2352 x 1568 pixels, 45° FOV, color fundus photograph
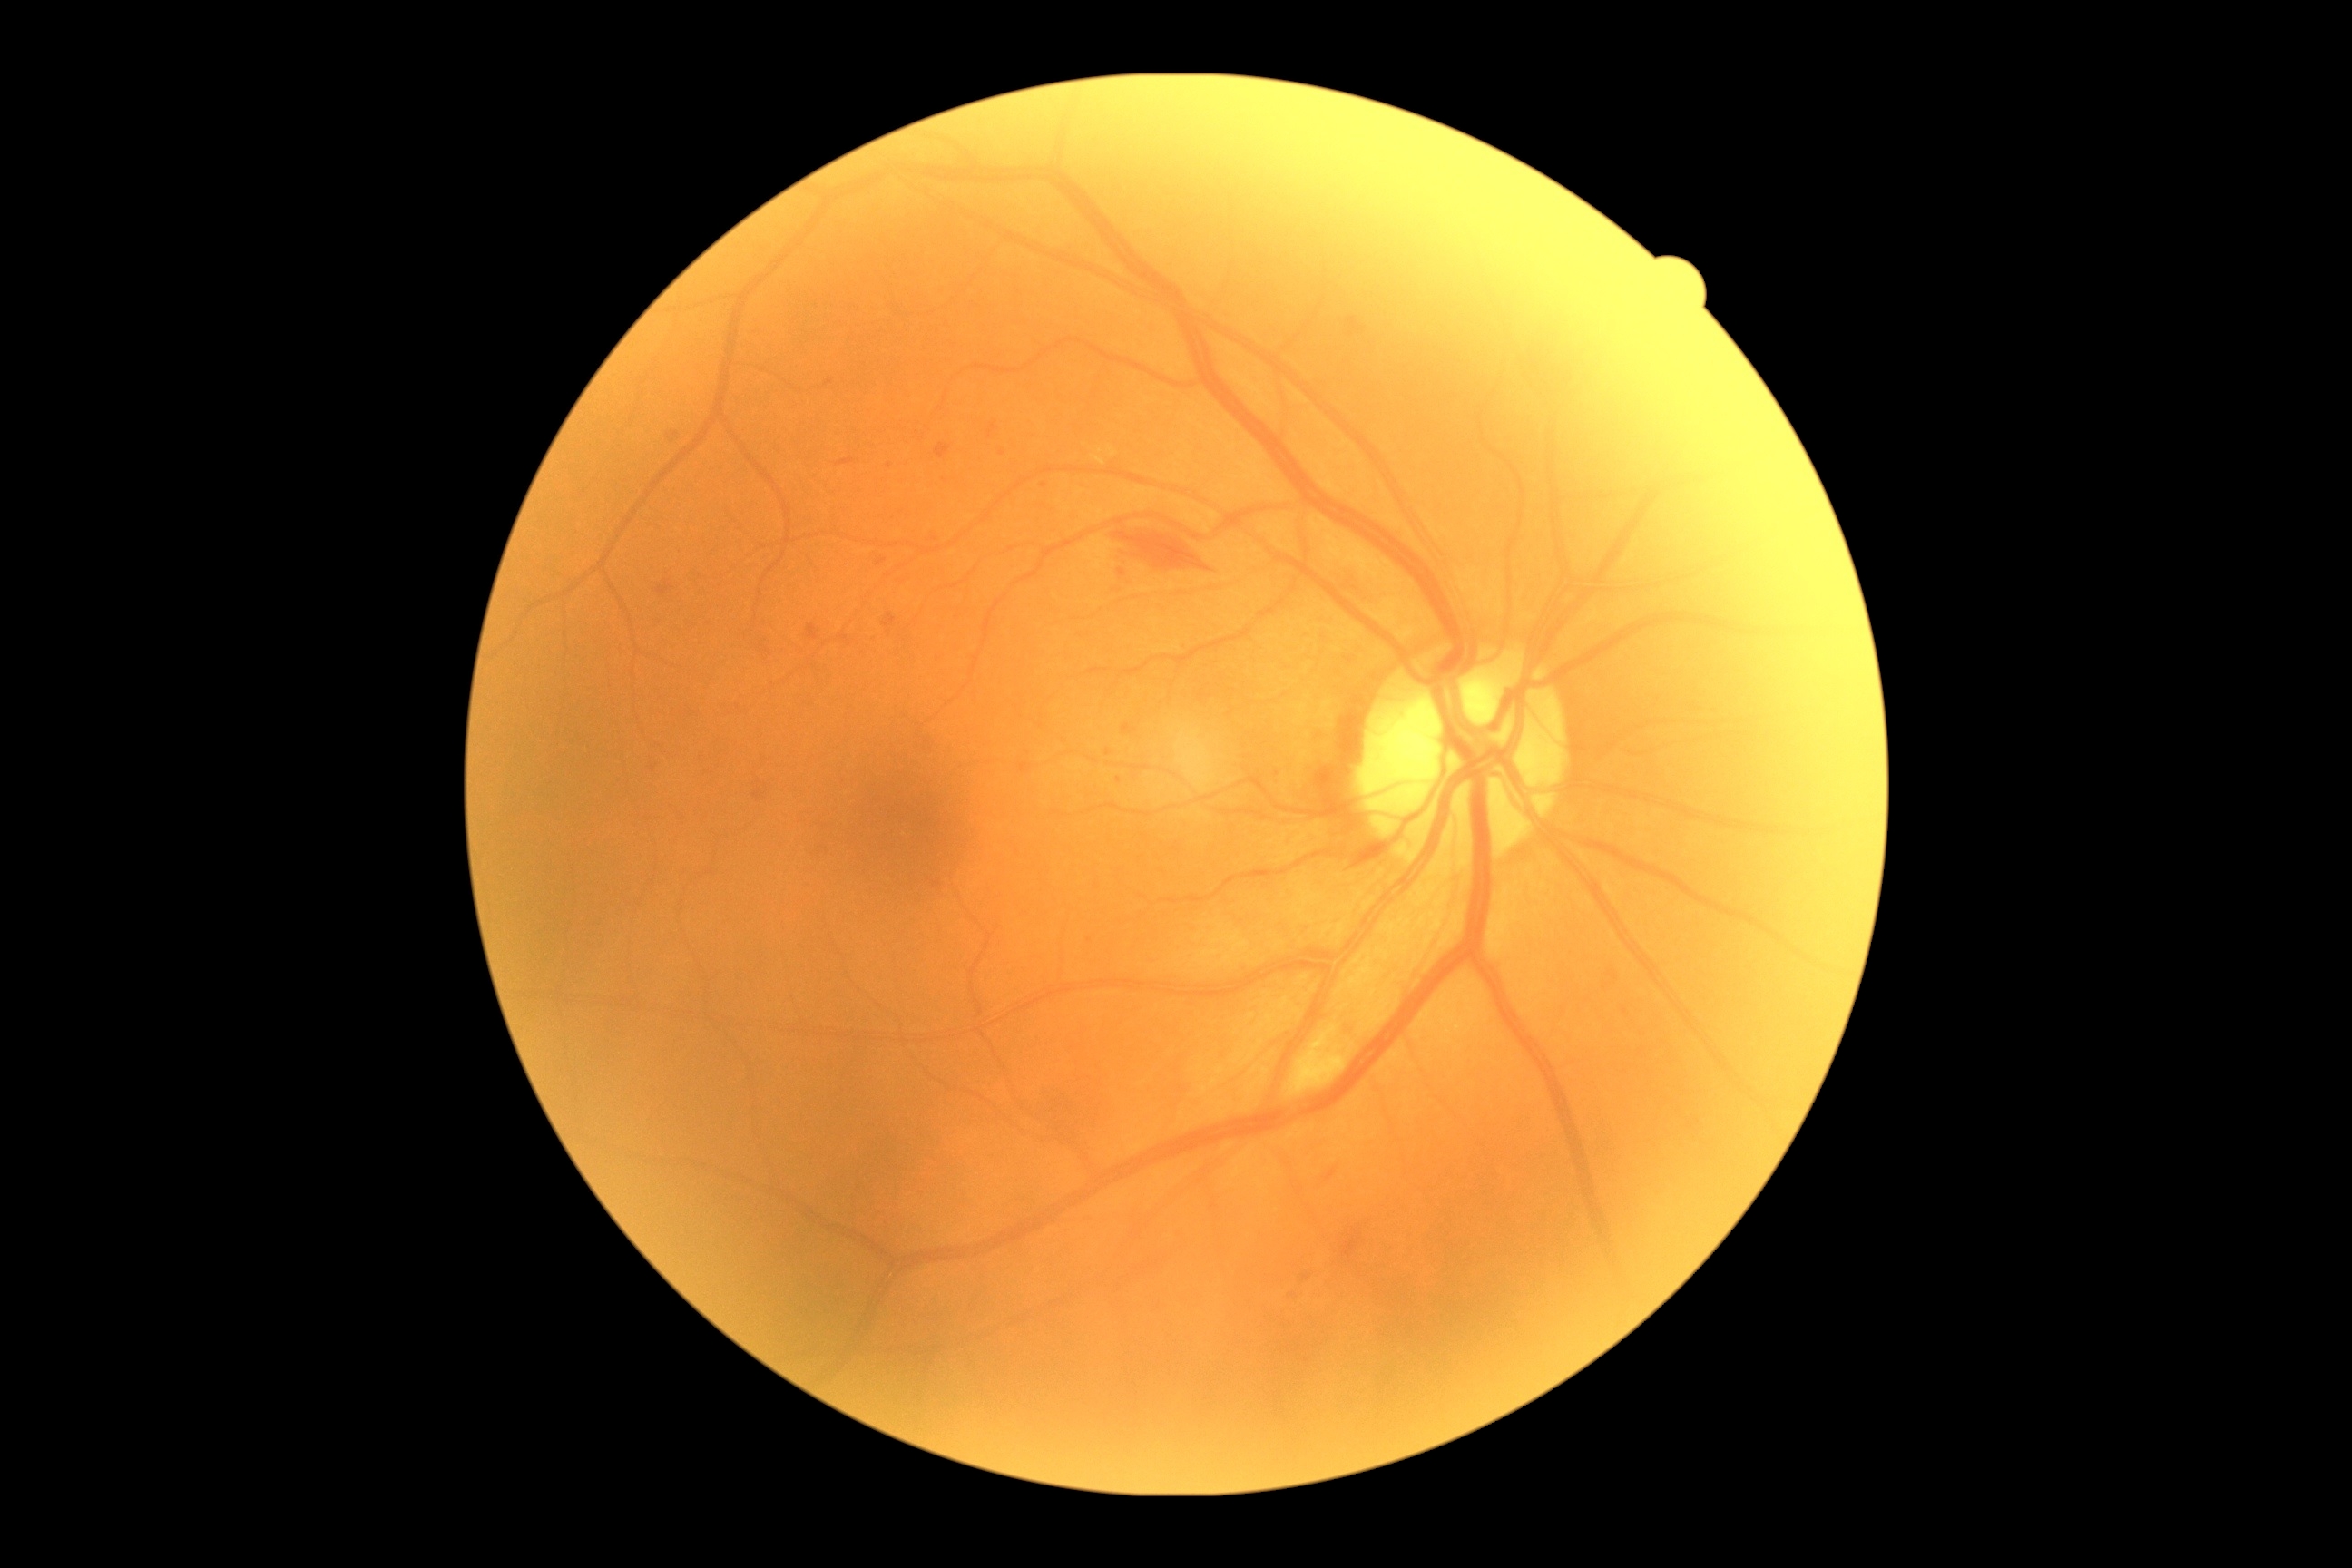
The retinopathy is classified as non-proliferative diabetic retinopathy. DR severity: 2.